Image size 848x848, graded on the modified Davis scale, acquired with a NIDEK AFC-230 — 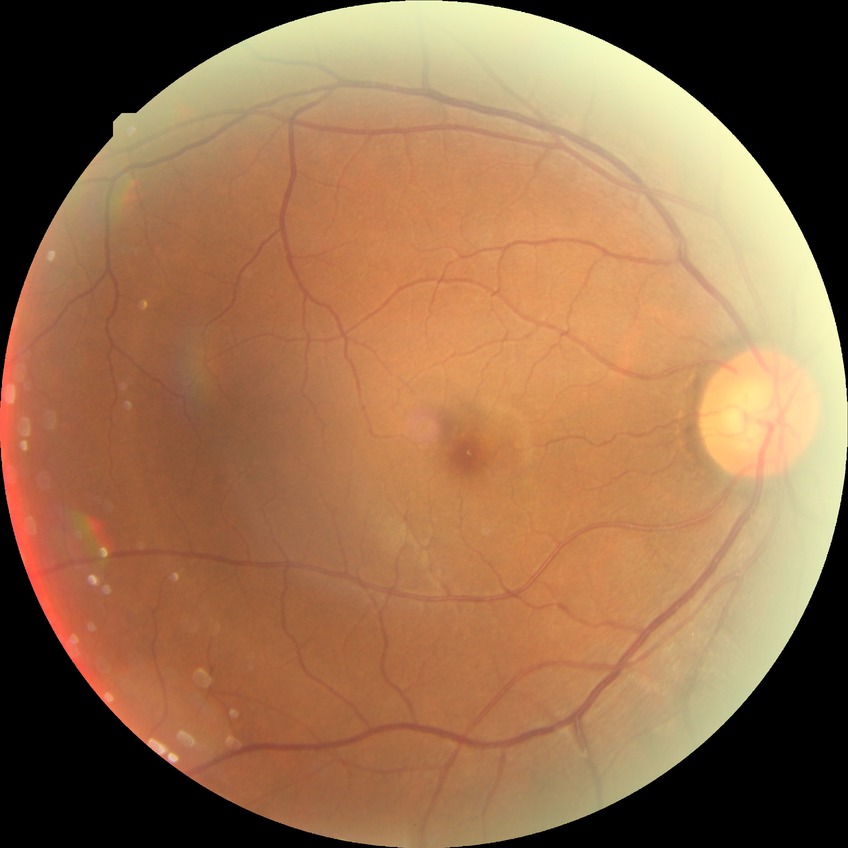 Findings:
– diabetic retinopathy (DR) — NDR (no diabetic retinopathy)